No pharmacologic dilation, 848x848px: 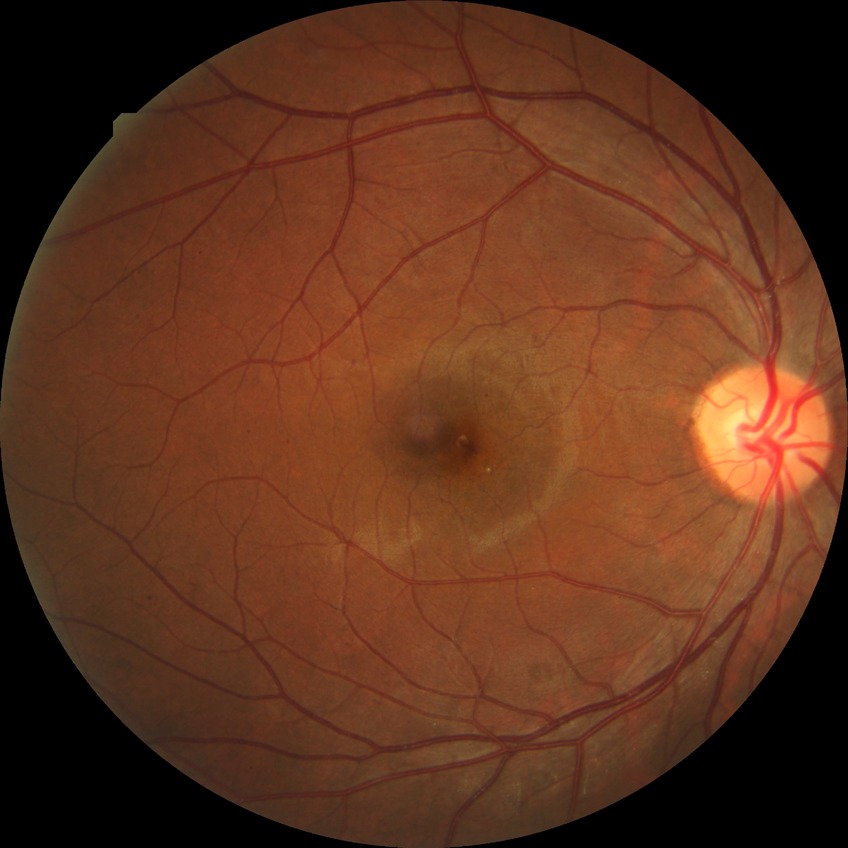 DR class=non-proliferative diabetic retinopathy; modified Davis classification=simple diabetic retinopathy.